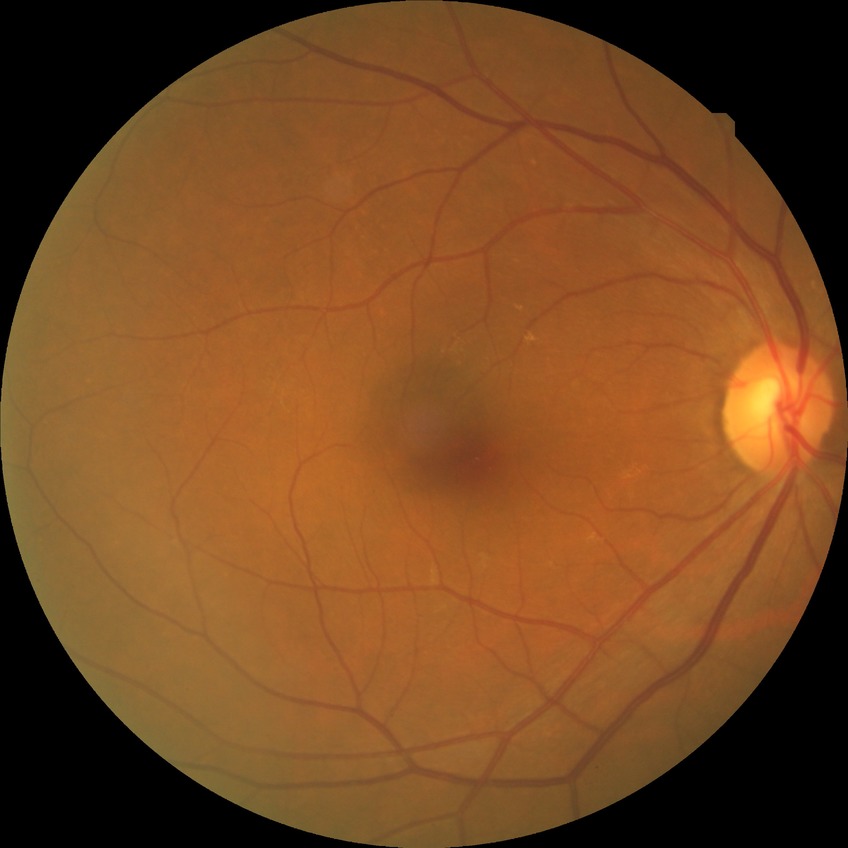
Retinopathy grade is no diabetic retinopathy.